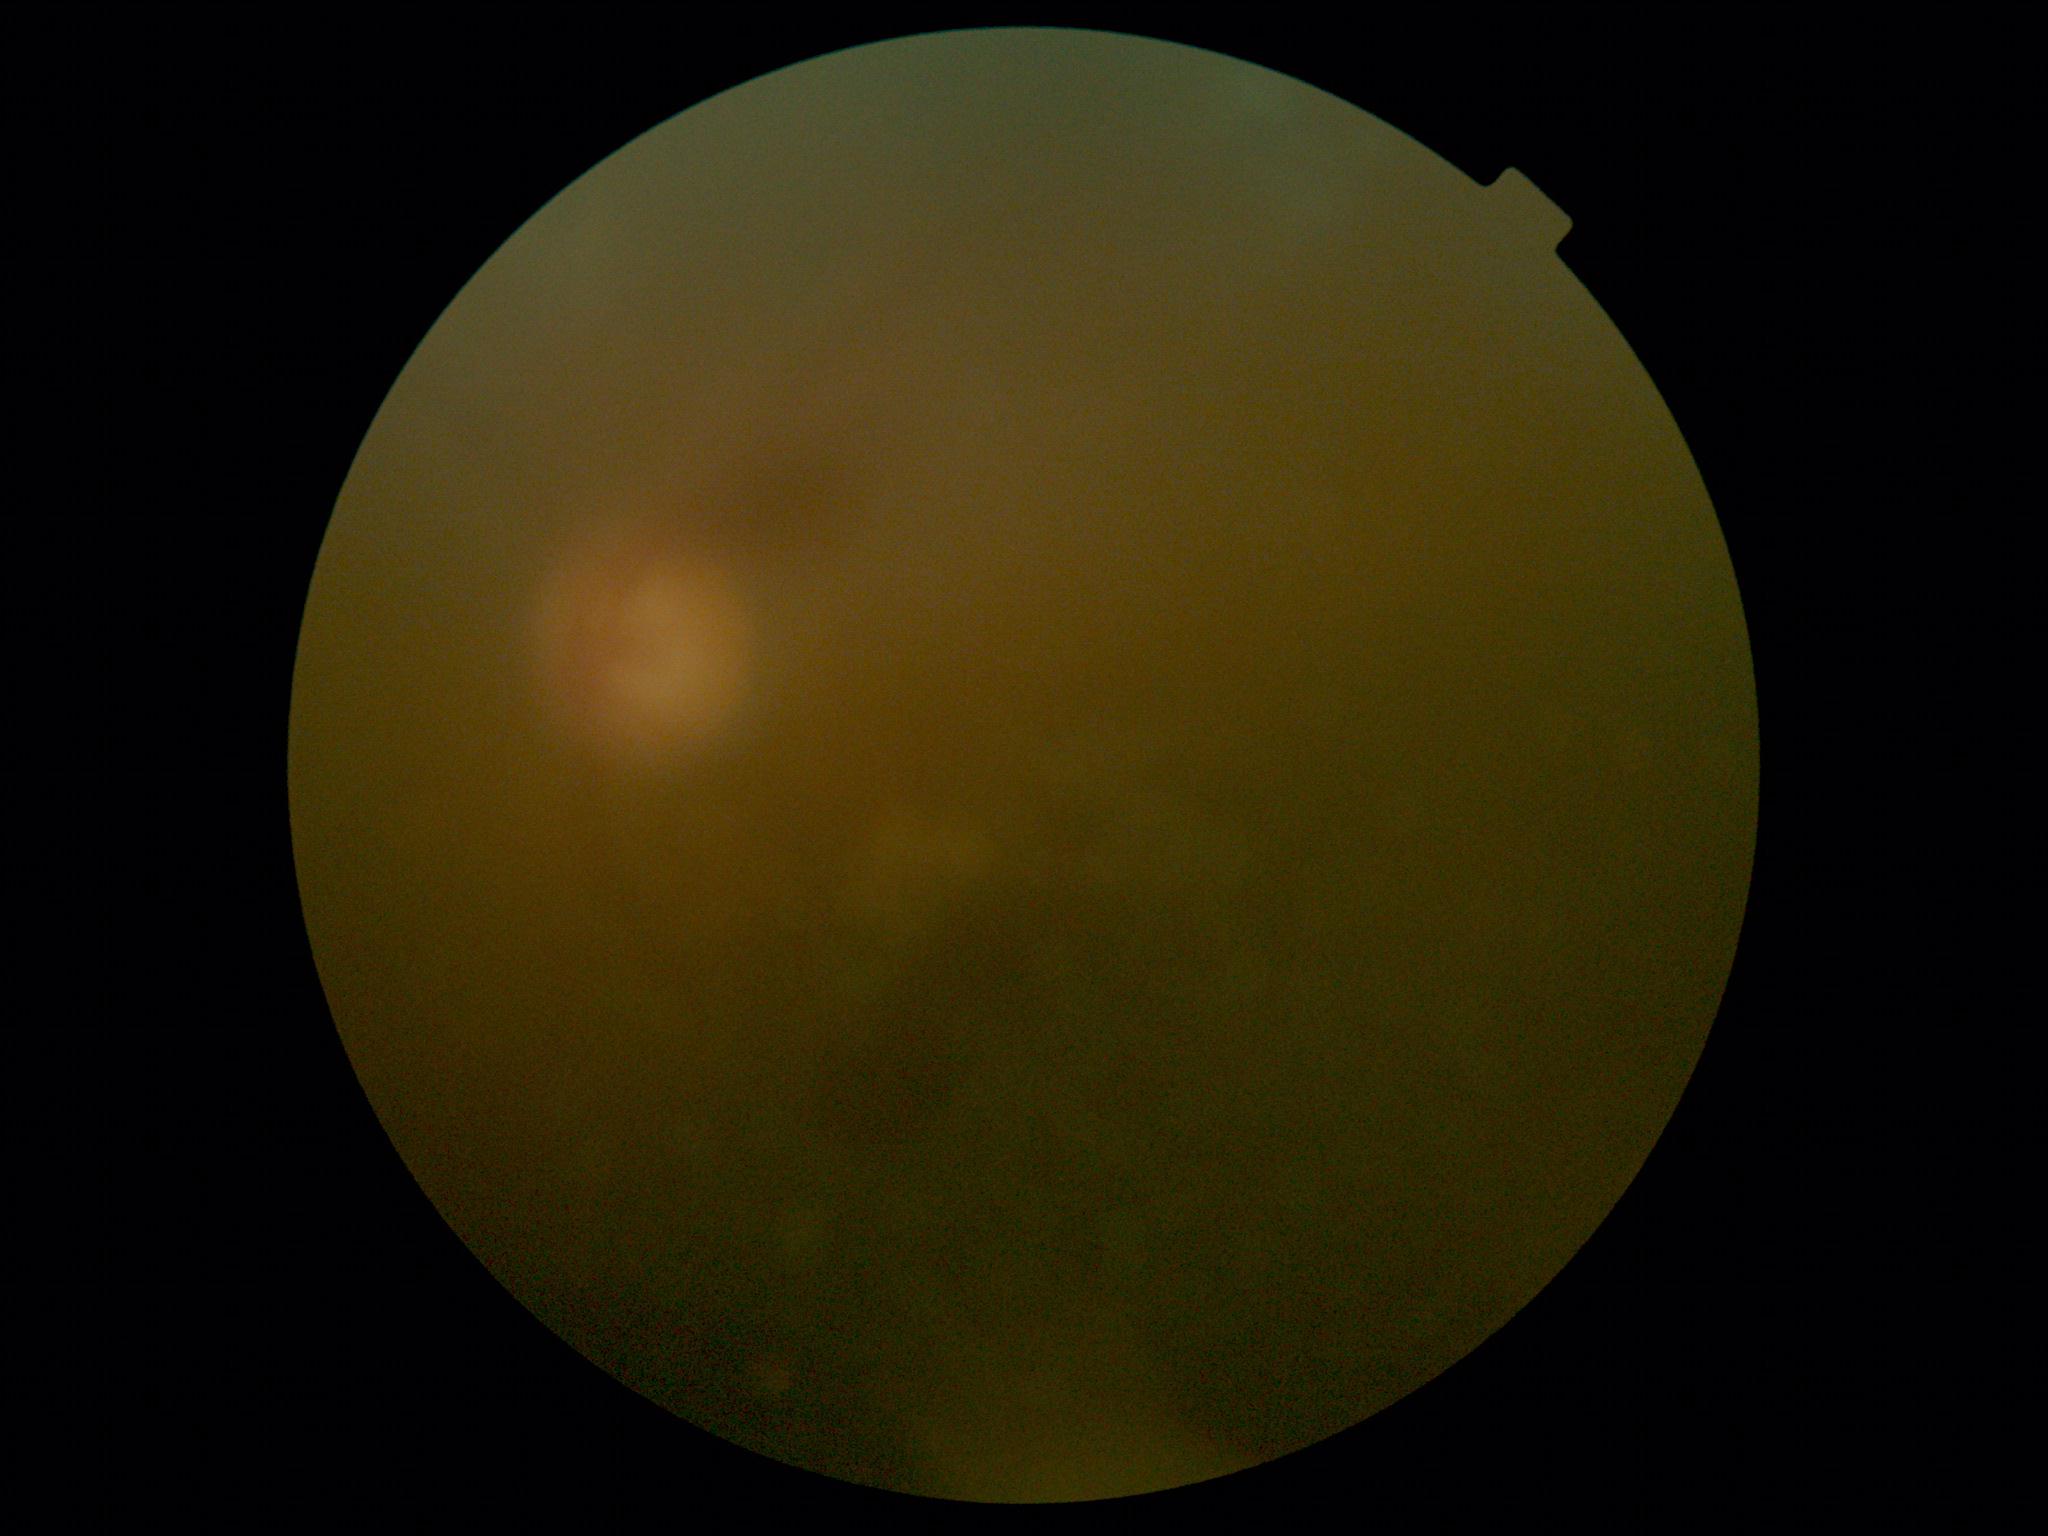 DR severity is ungradable due to poor image quality.
The image cannot be graded for diabetic retinopathy.